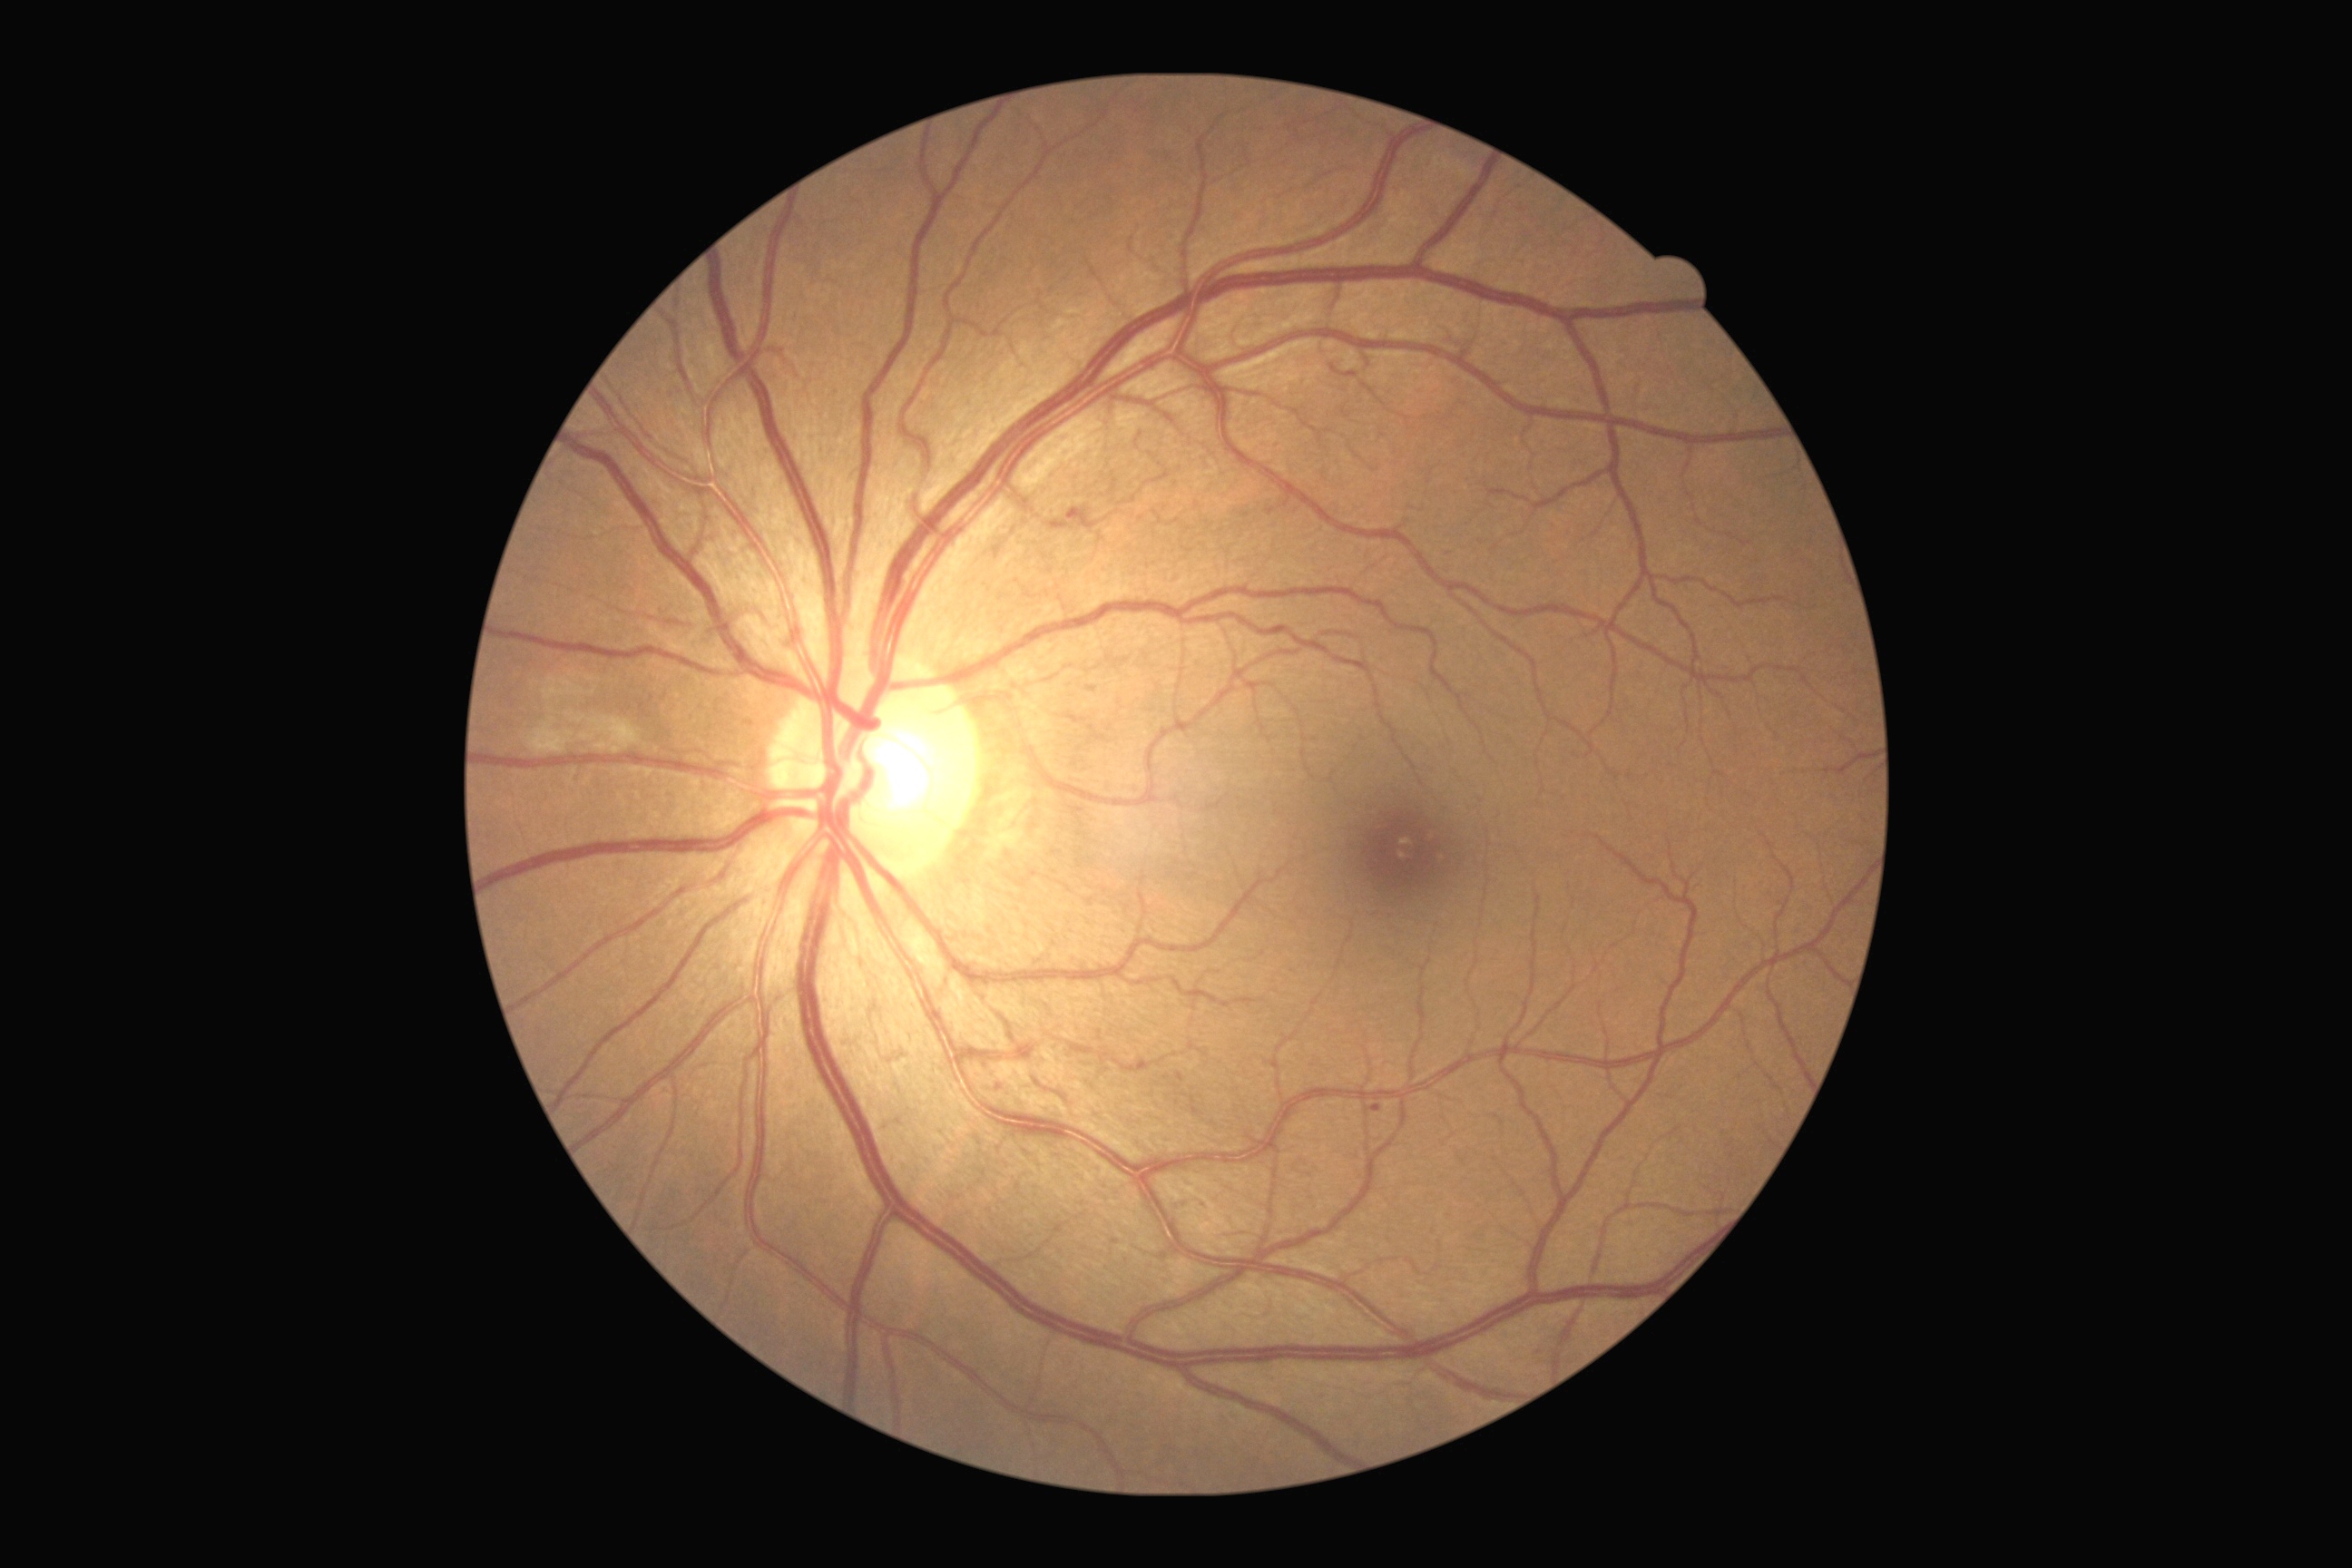

diabetic retinopathy (DR): grade 2 (moderate NPDR)